Nonmydriatic — 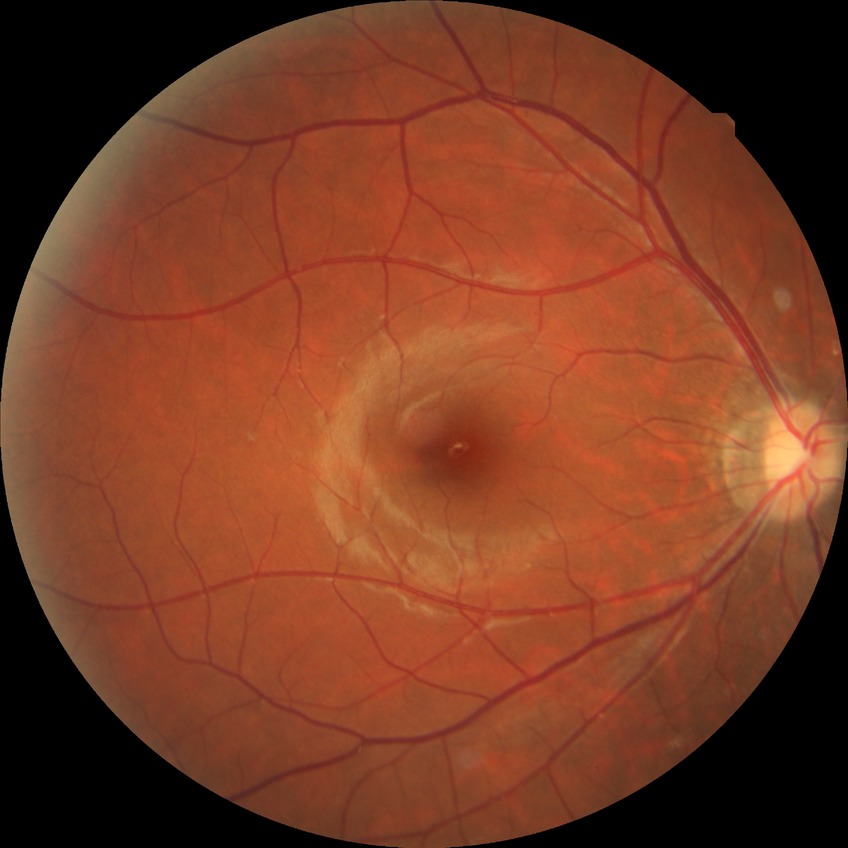

diabetic retinopathy (DR): NDR (no diabetic retinopathy).